Color fundus image — 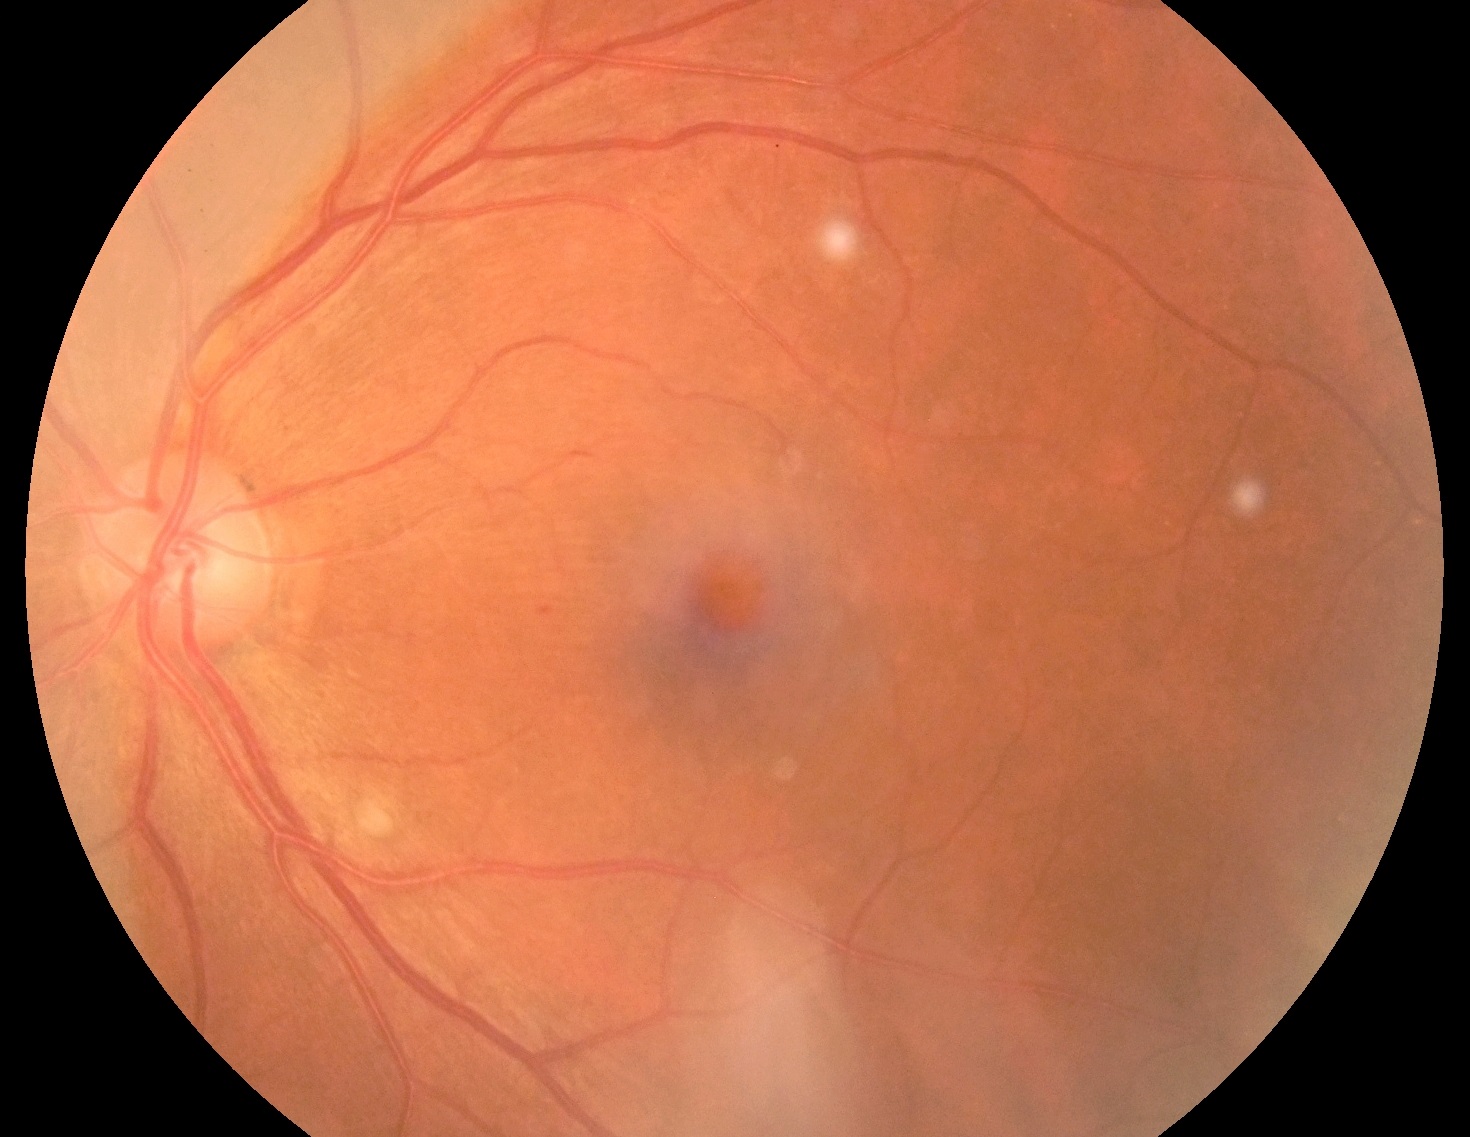 DR stage: 2.